1659x2212px:
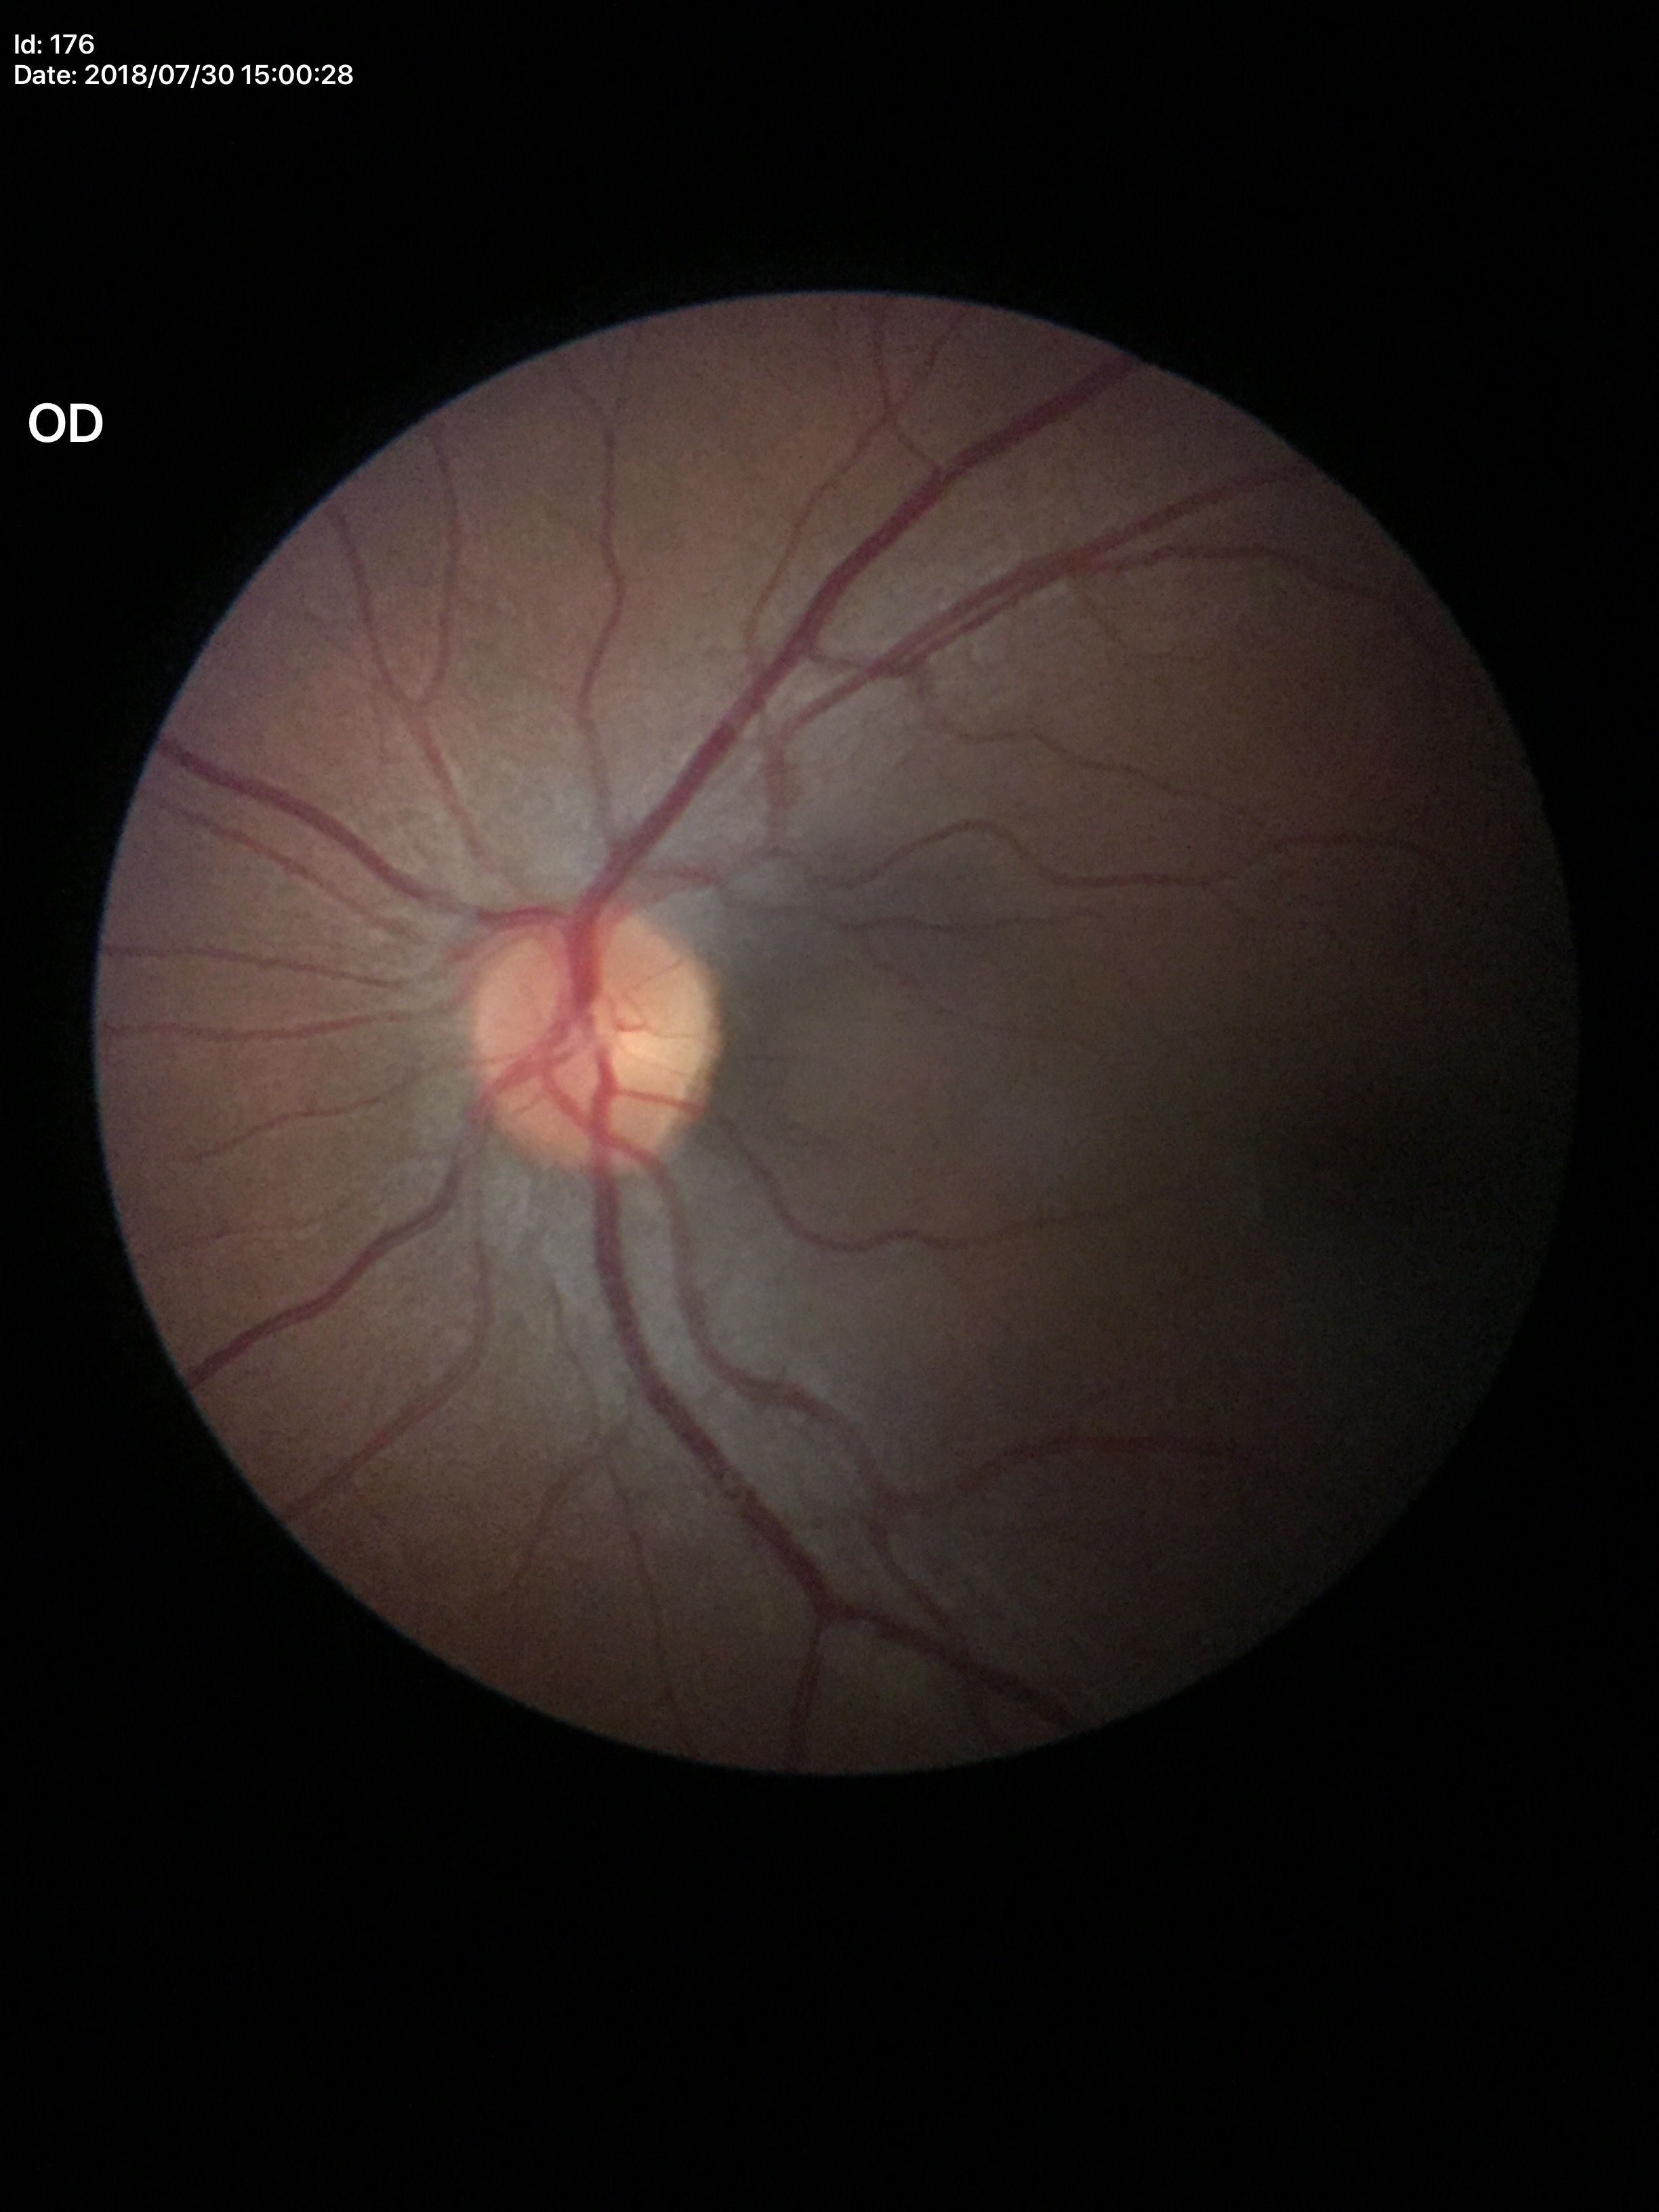 No glaucomatous optic neuropathy. Vertical cup-to-disc ratio is 0.48.